45° field of view · color fundus image · 1725 by 1721 pixels: 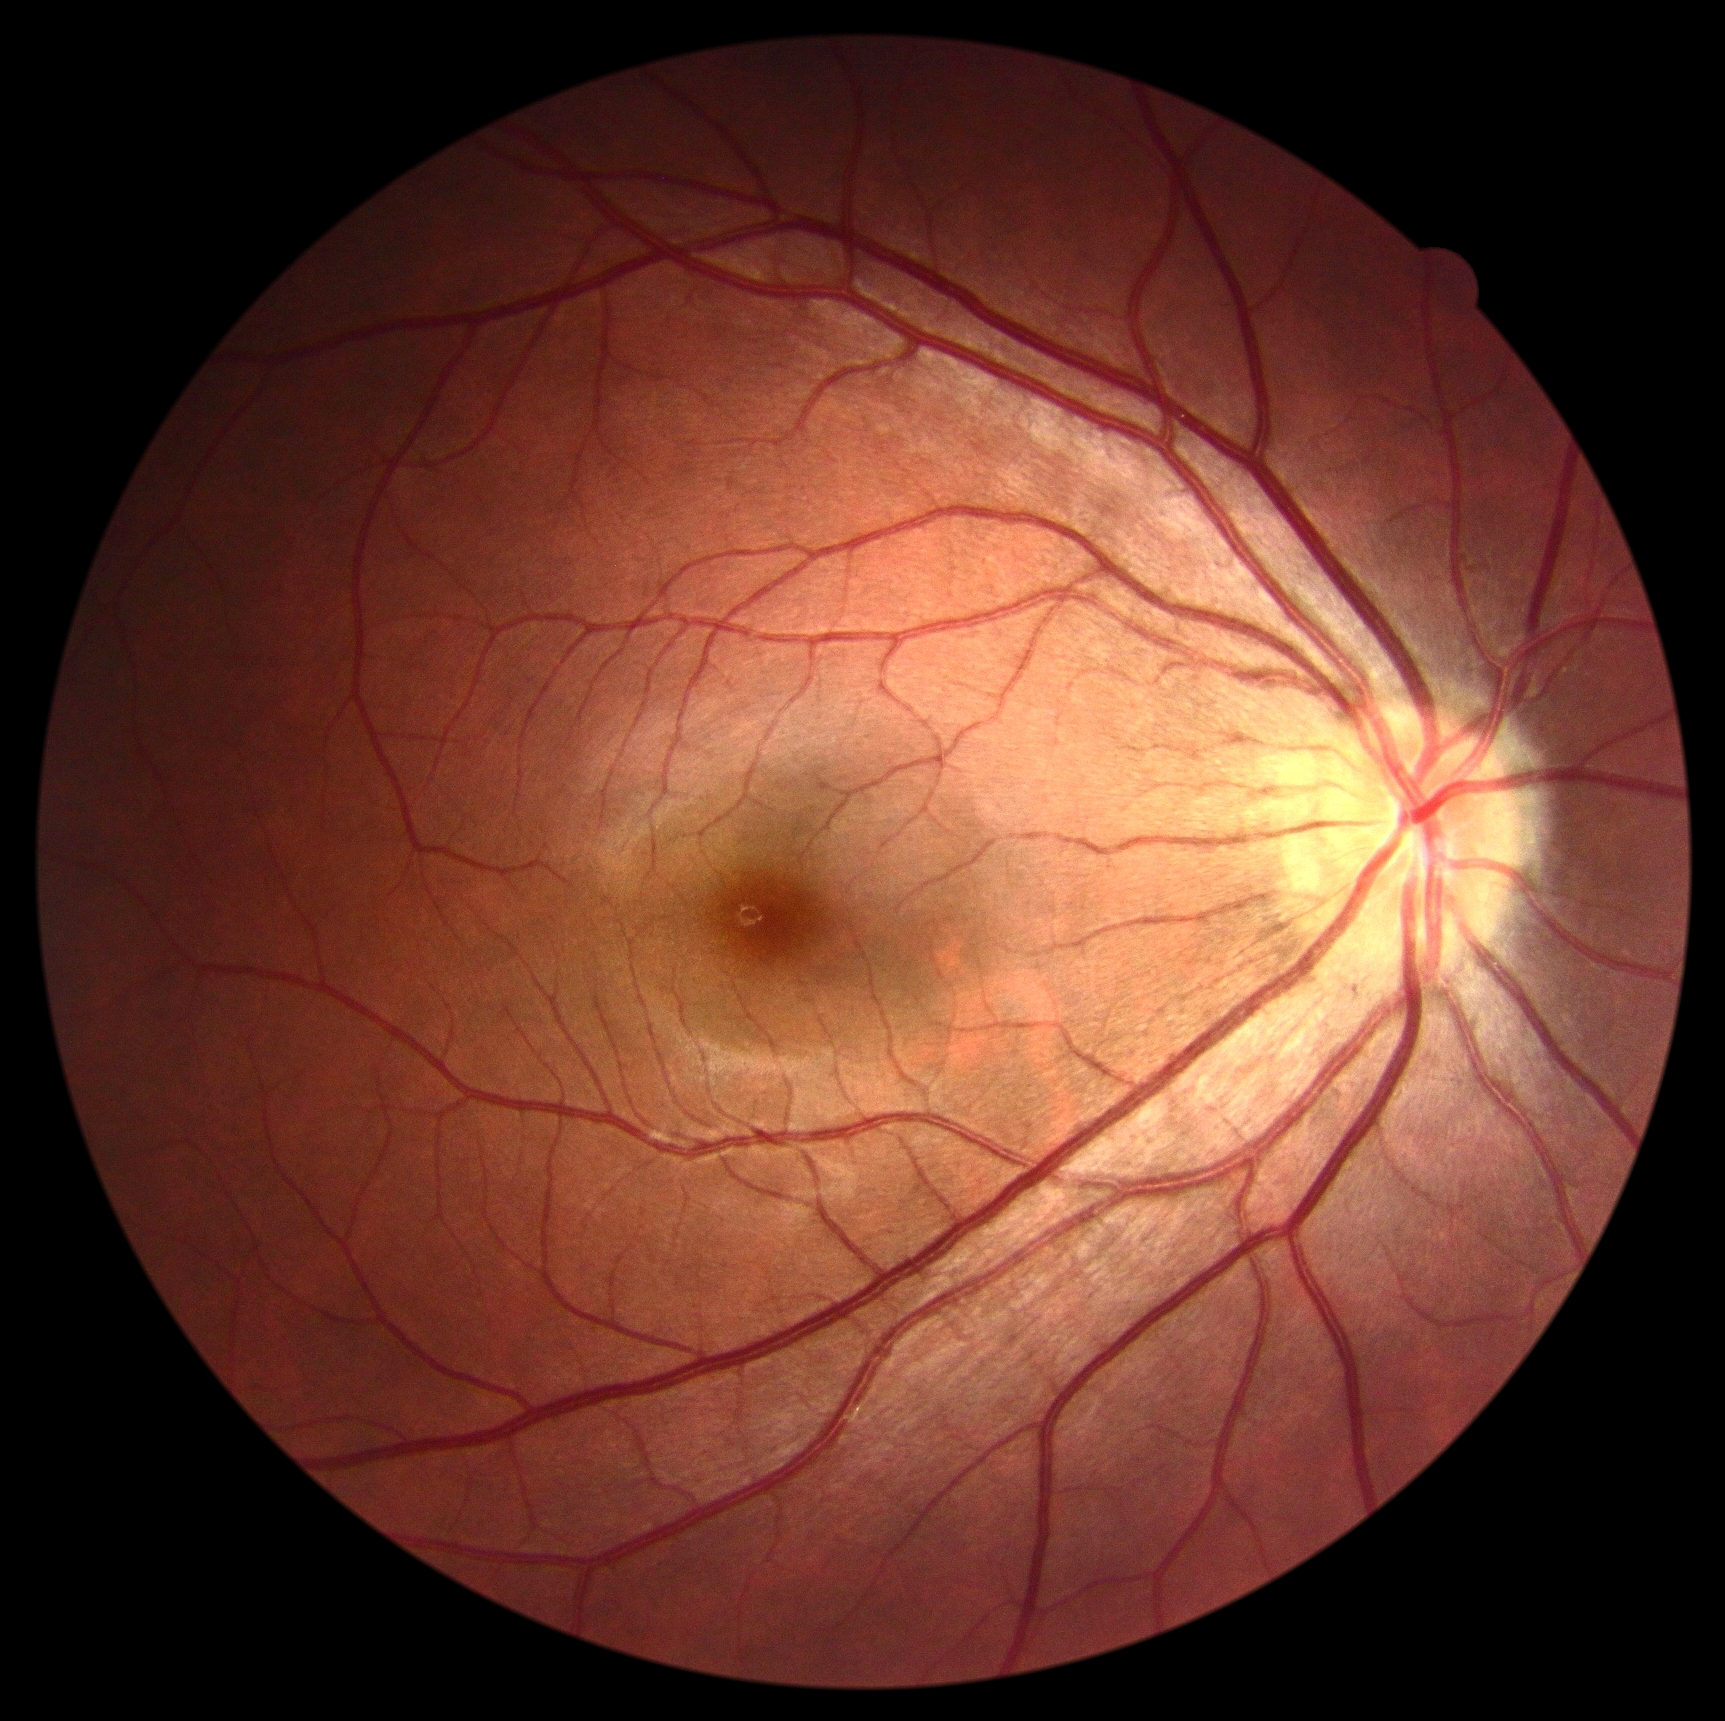 No diabetic retinal disease findings. DR stage is 0/4 — no visible signs of diabetic retinopathy.